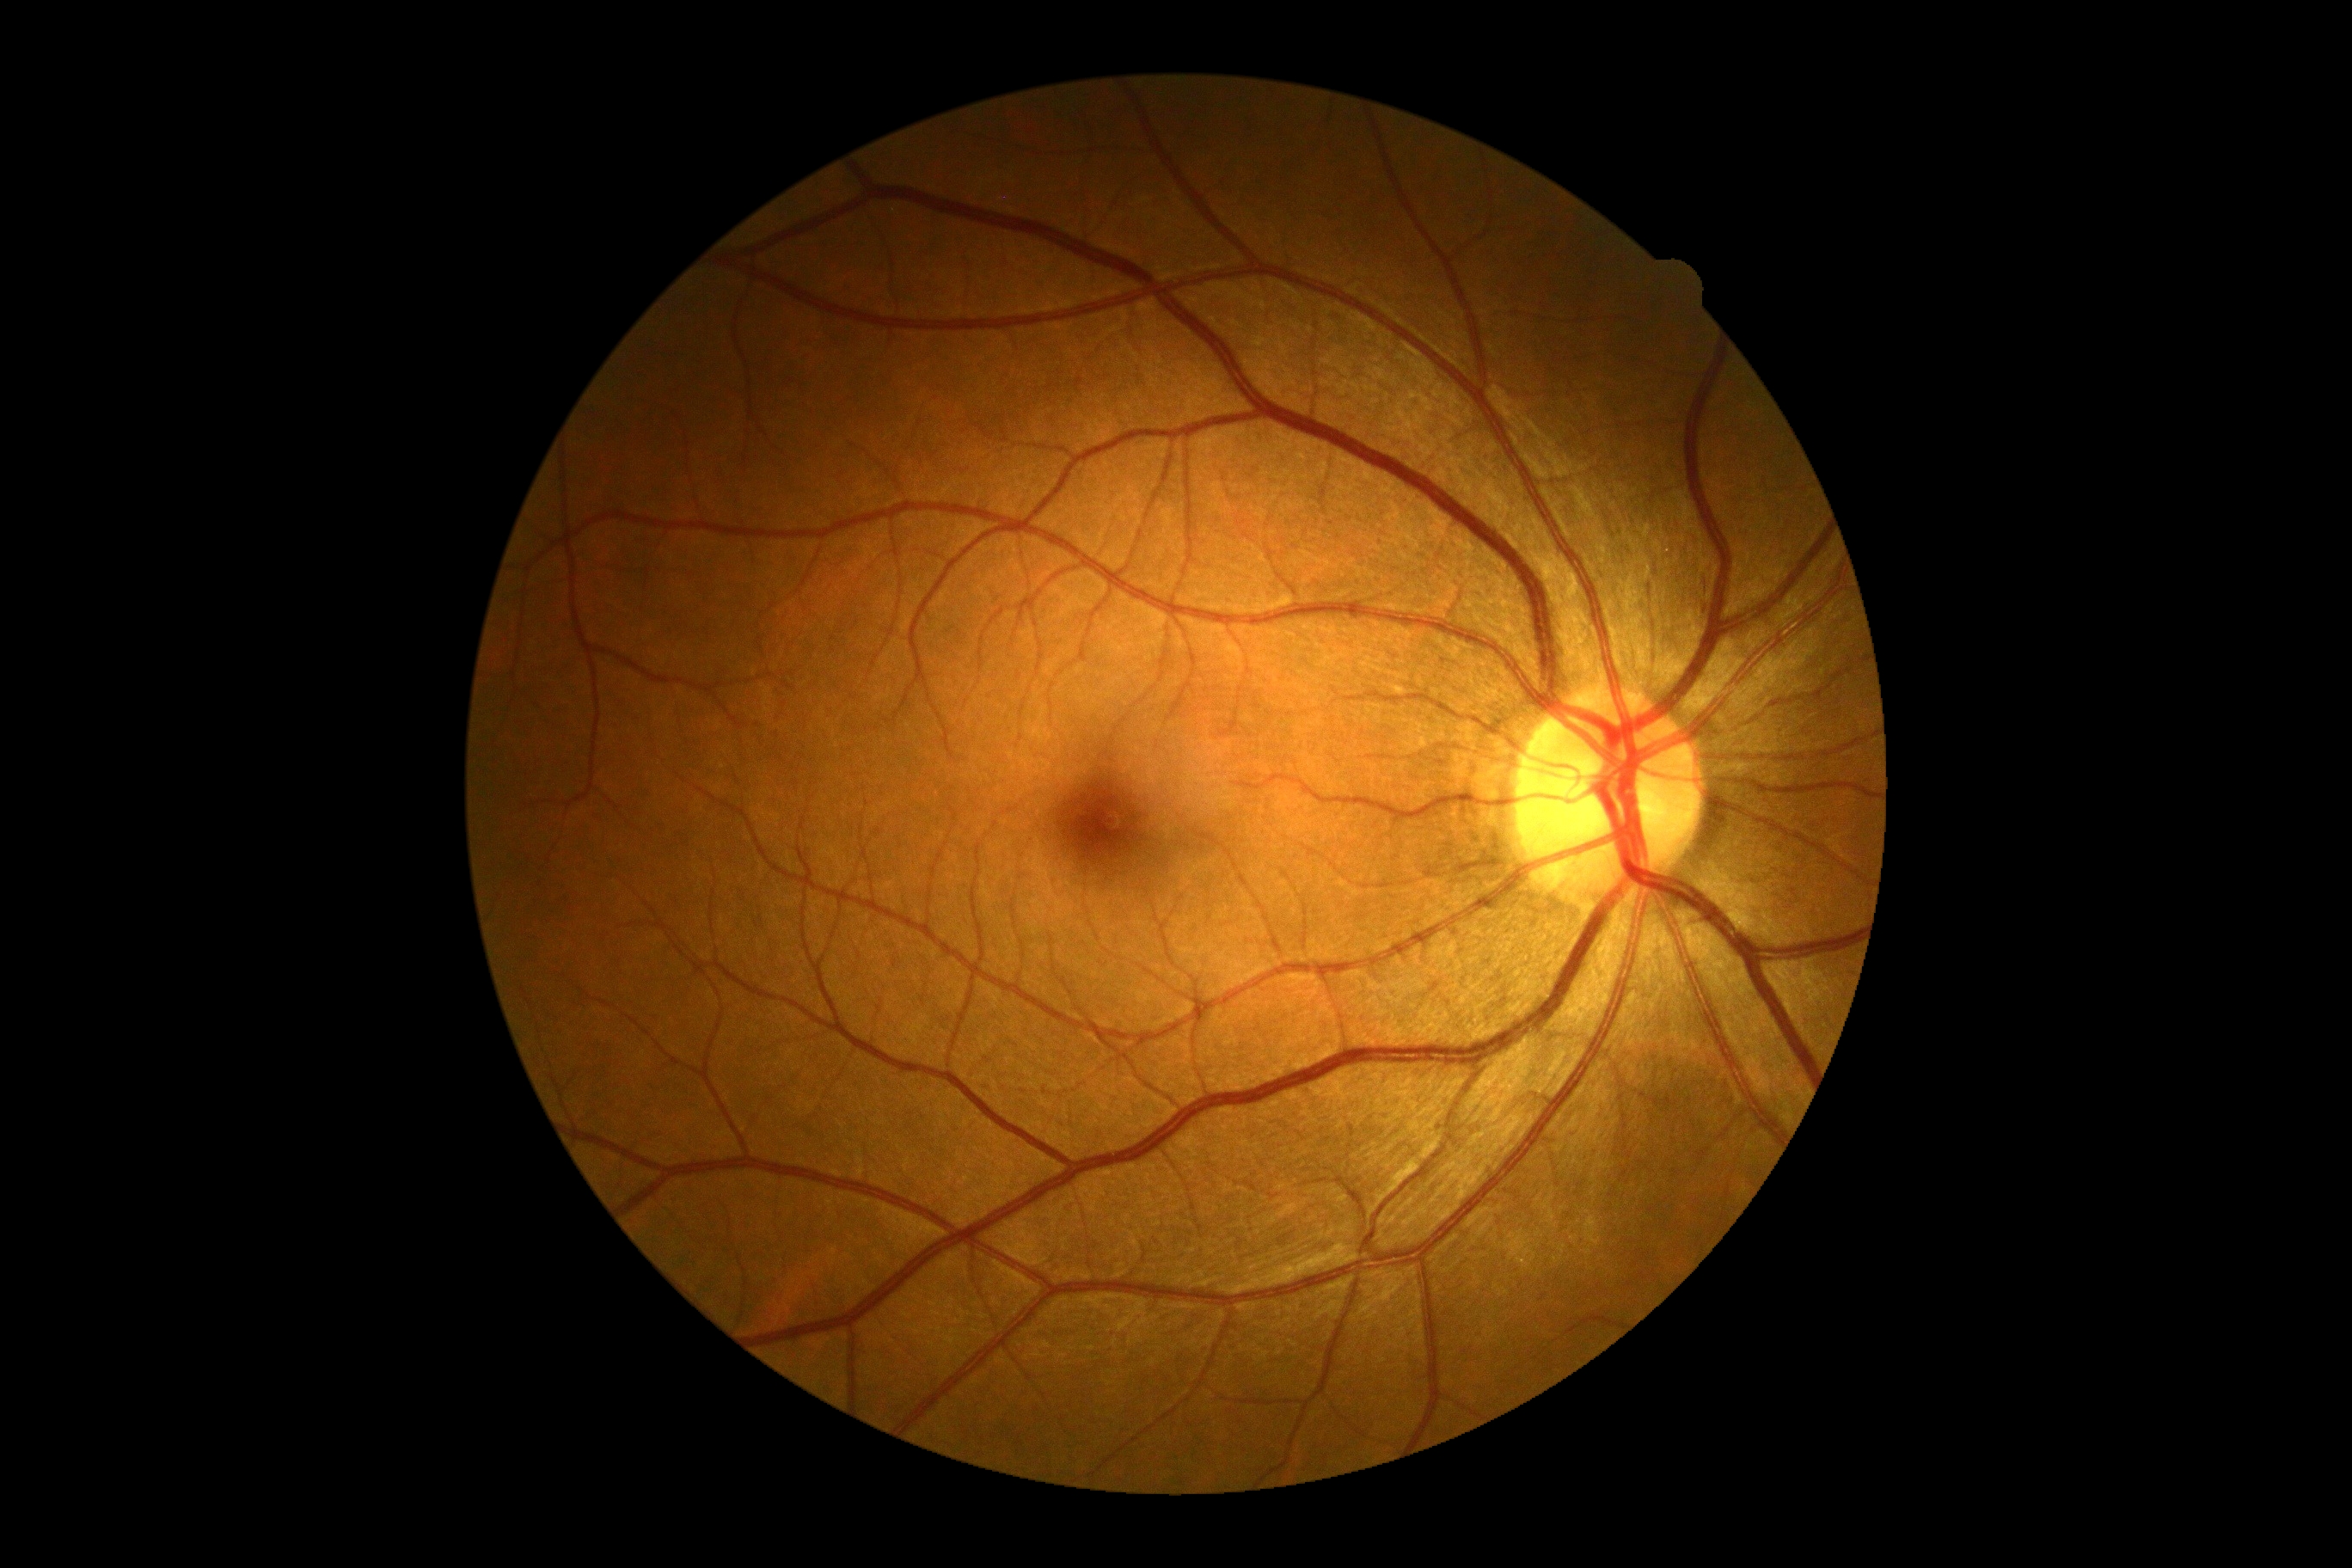 Diabetic retinopathy: grade 0 (no apparent retinopathy).